Infant wide-field retinal image
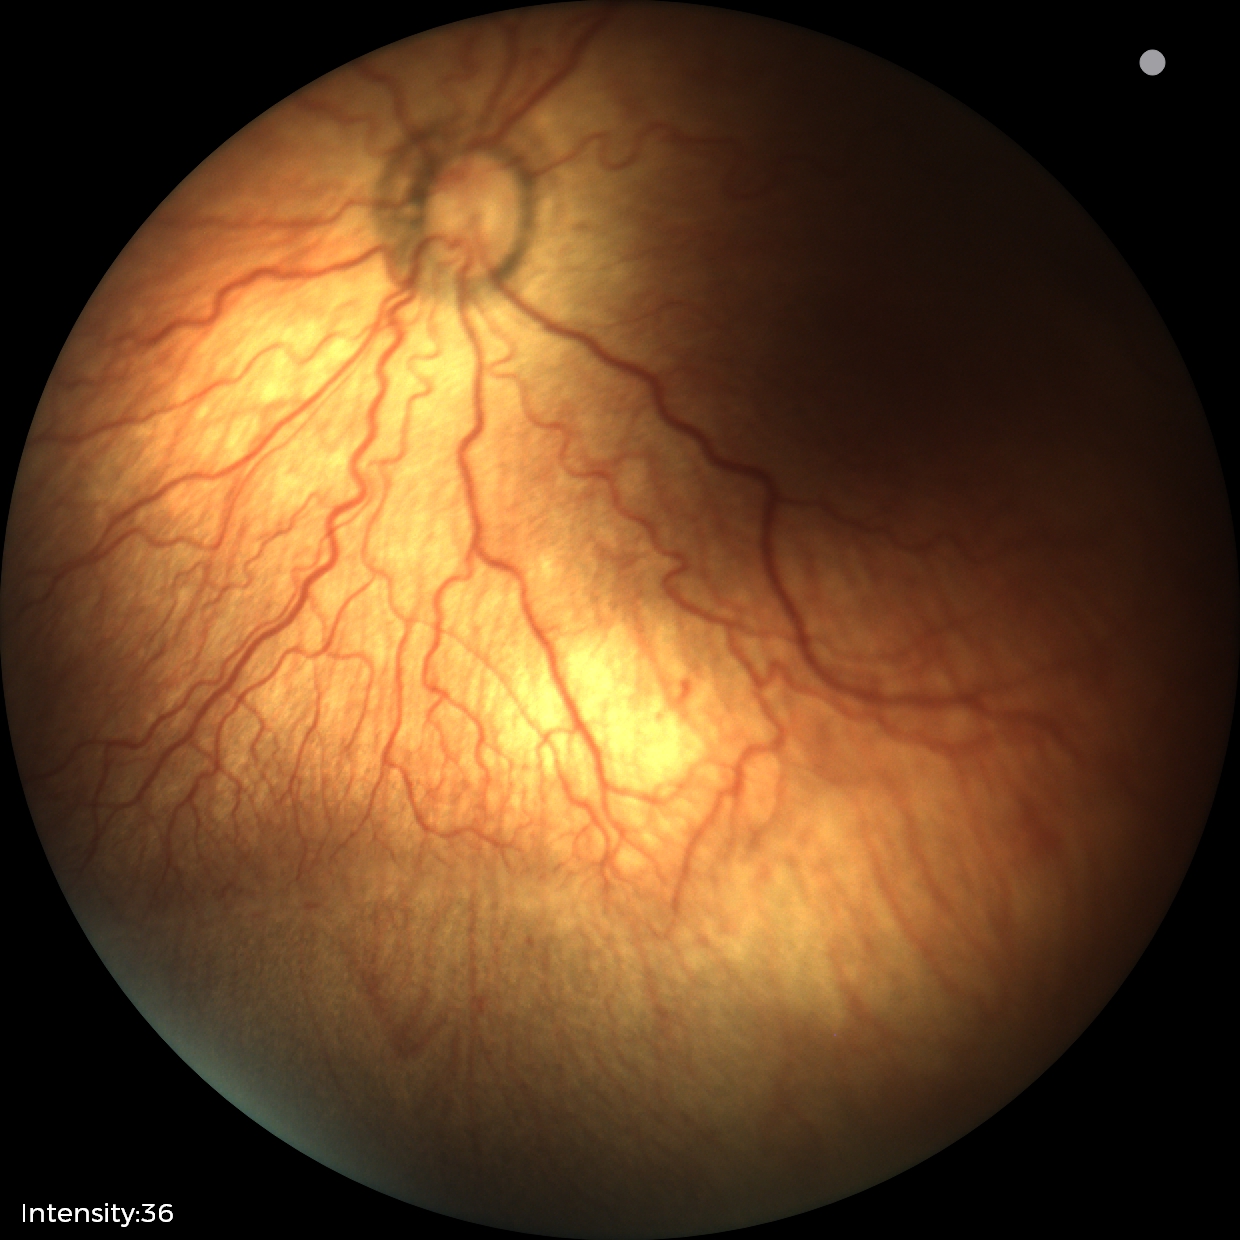 Screening series with retinopathy of prematurity stage 2. Plus disease was diagnosed.